848 x 848 pixels · Davis DR grading: 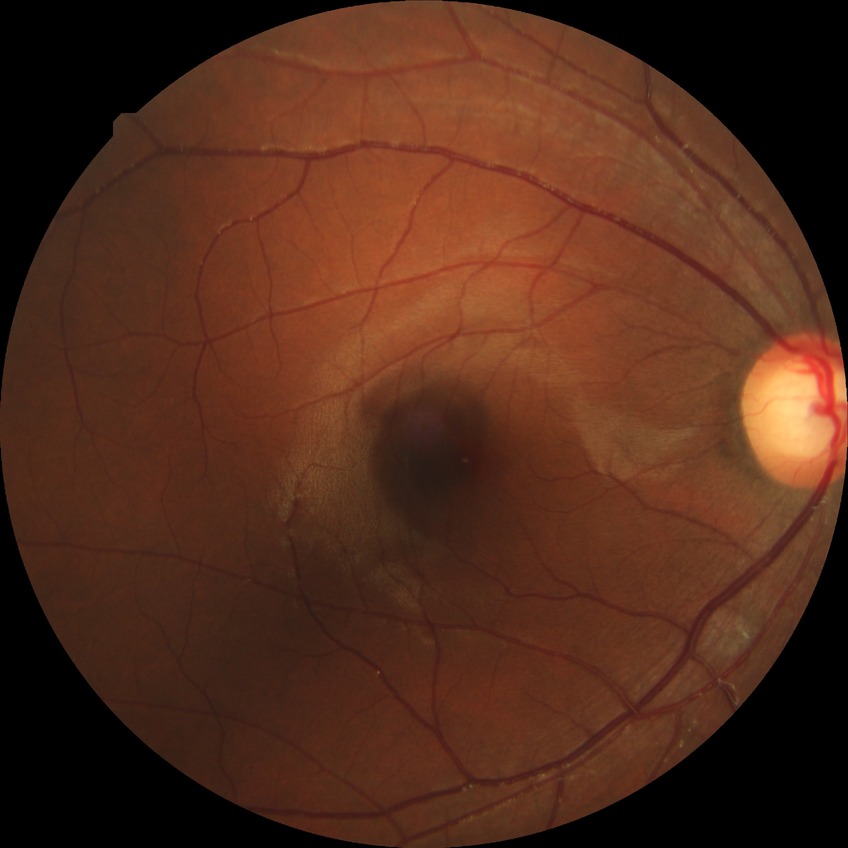
Annotations:
* retinopathy grade — simple diabetic retinopathy